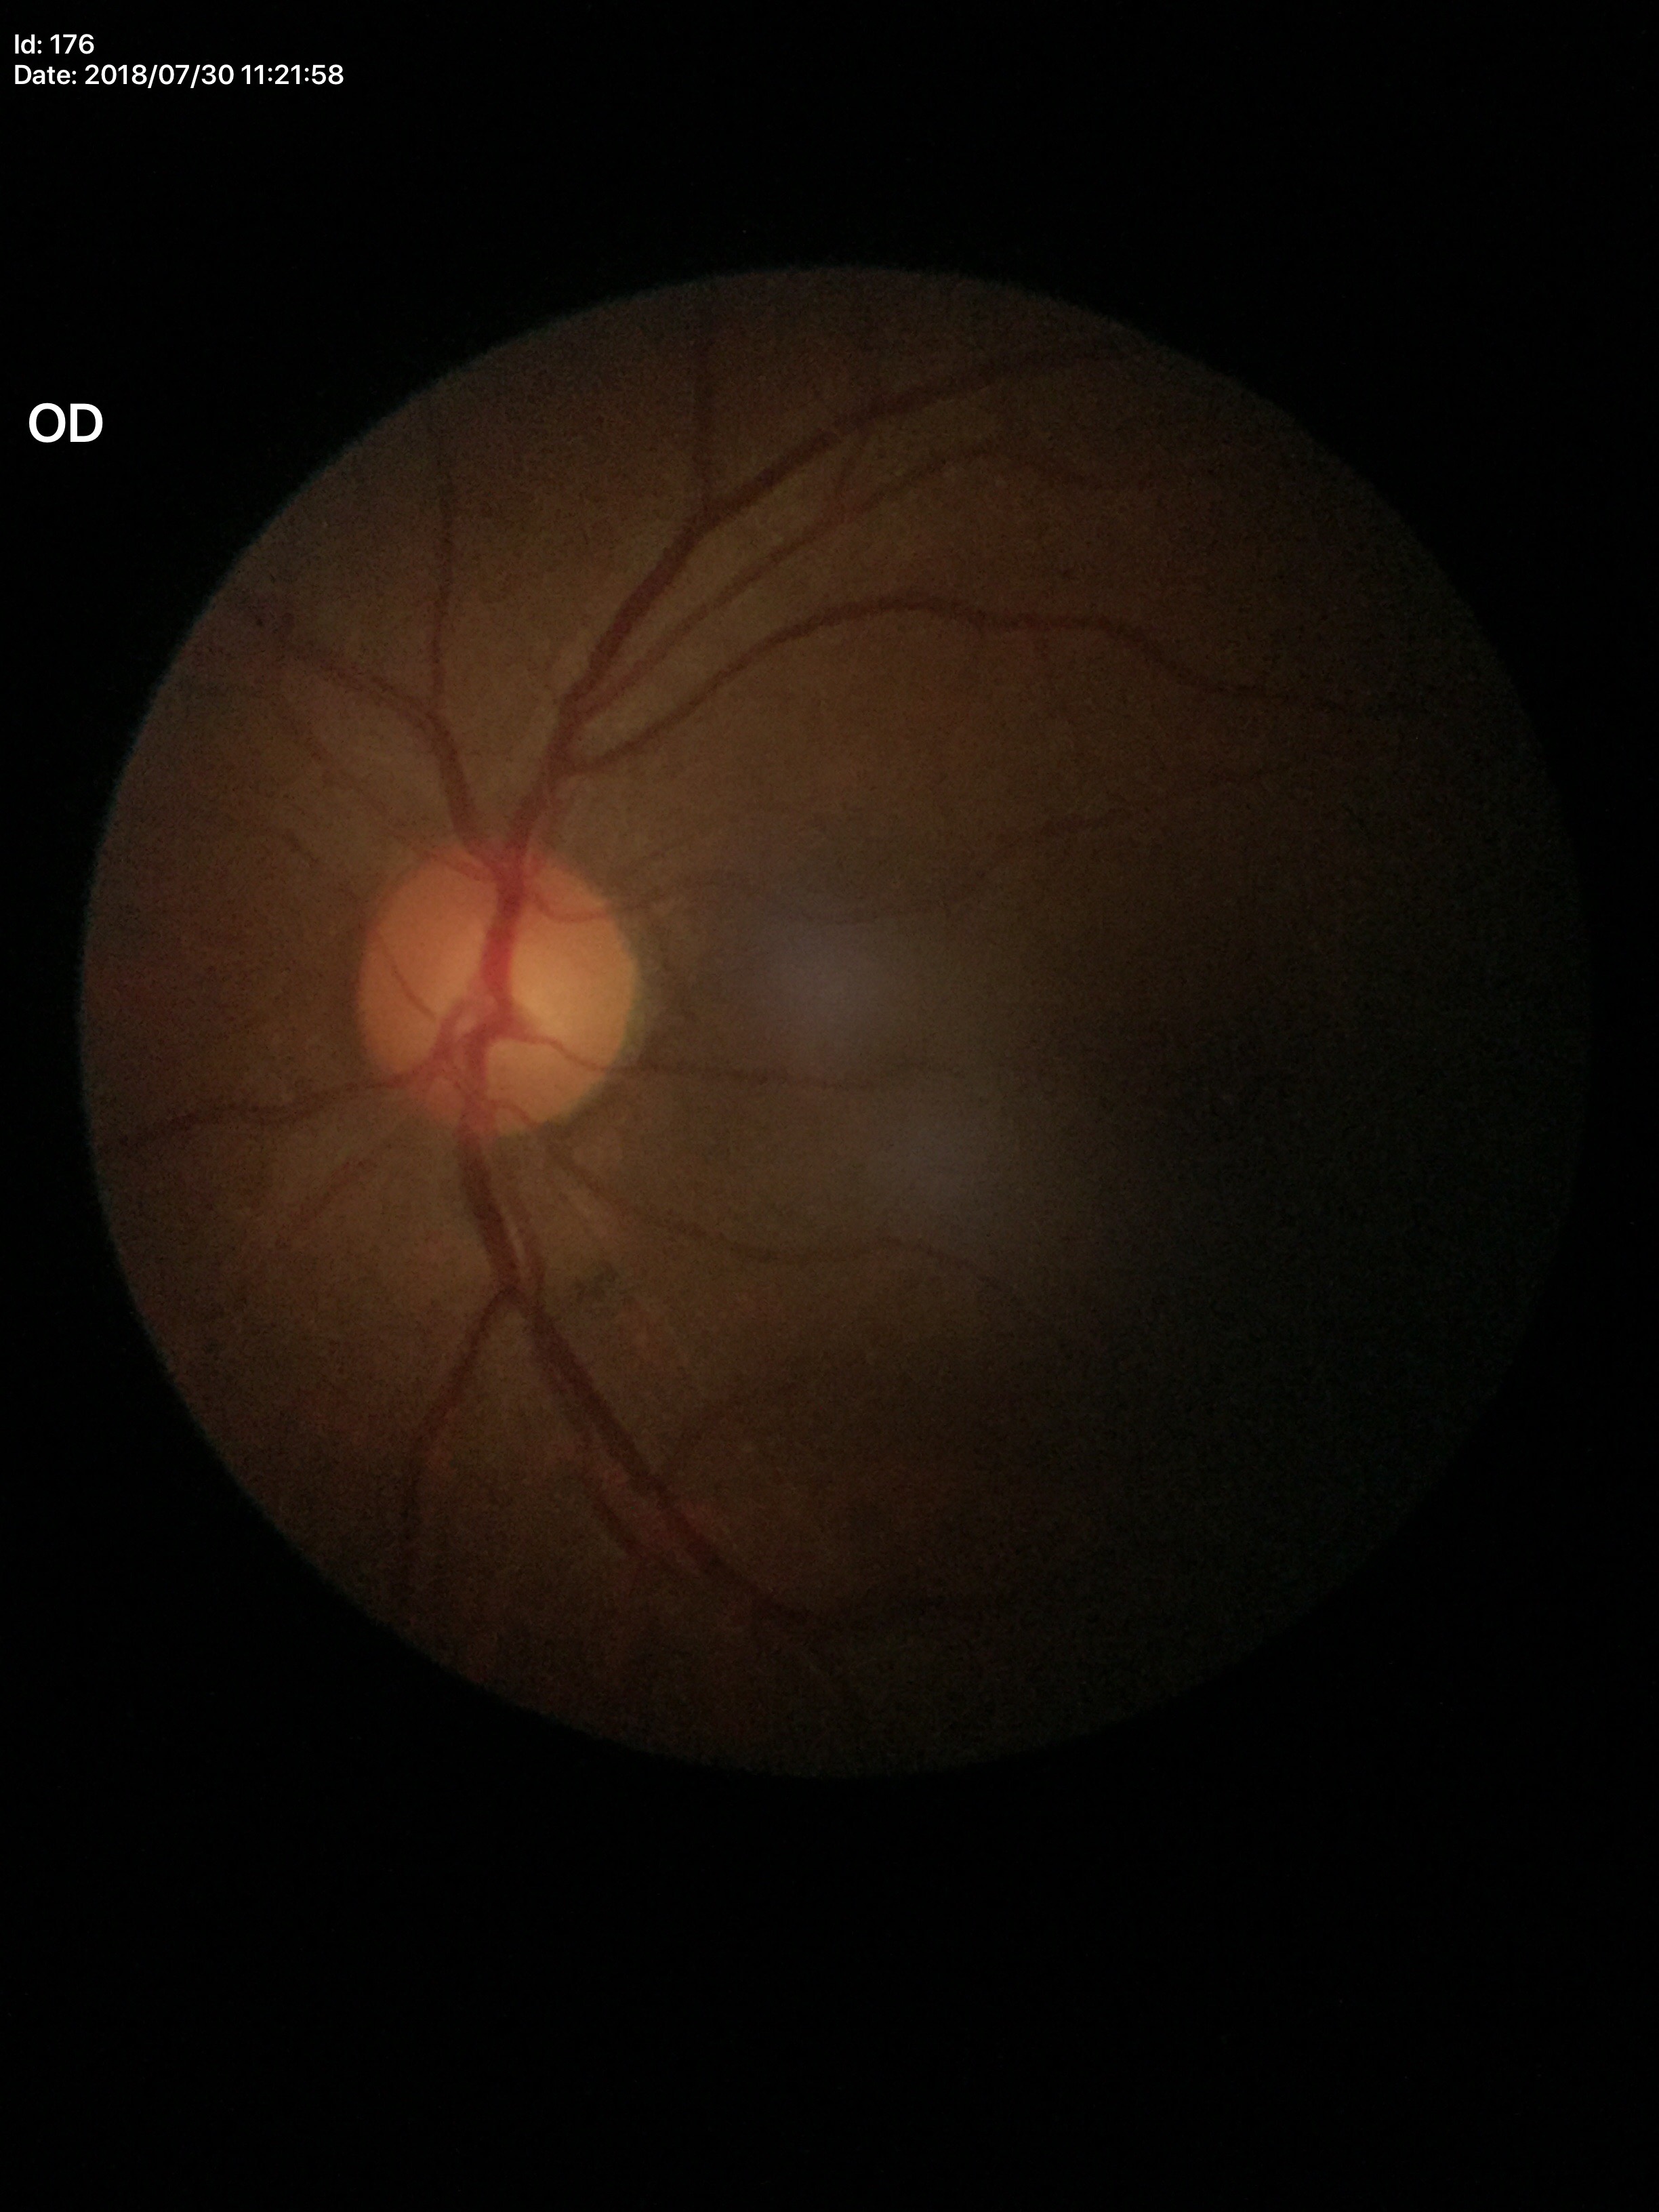 No glaucomatous findings (all 5 graders called normal). Vertical cup-to-disc ratio: 0.52.